Nonmydriatic fundus photograph: 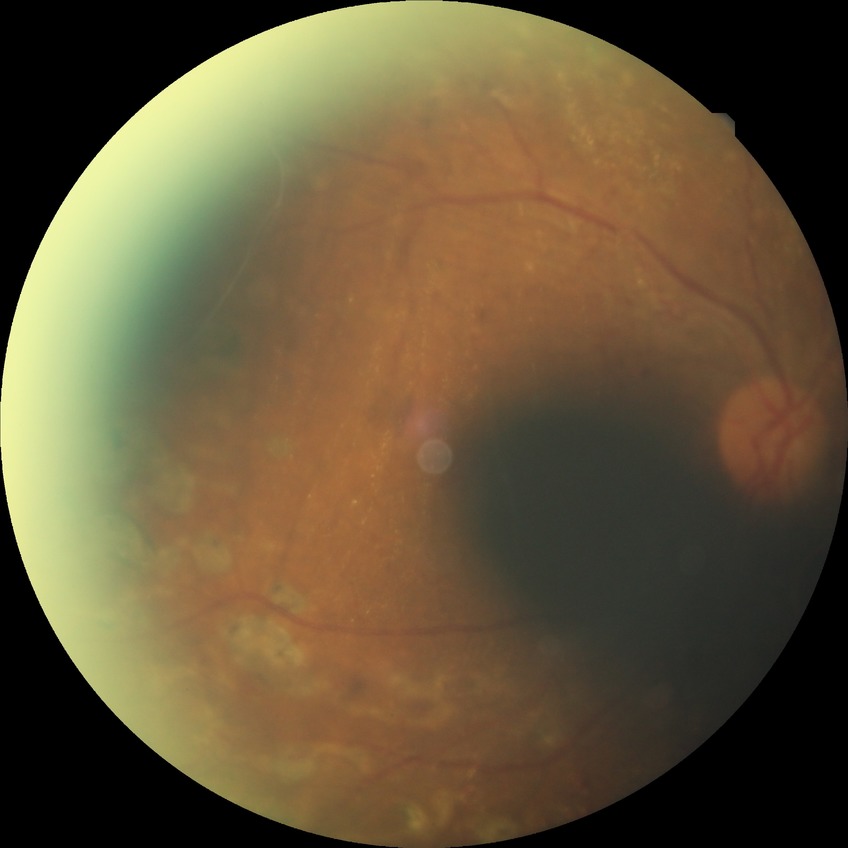

Assessment:
– diabetic retinopathy (DR) — PDR (proliferative diabetic retinopathy)